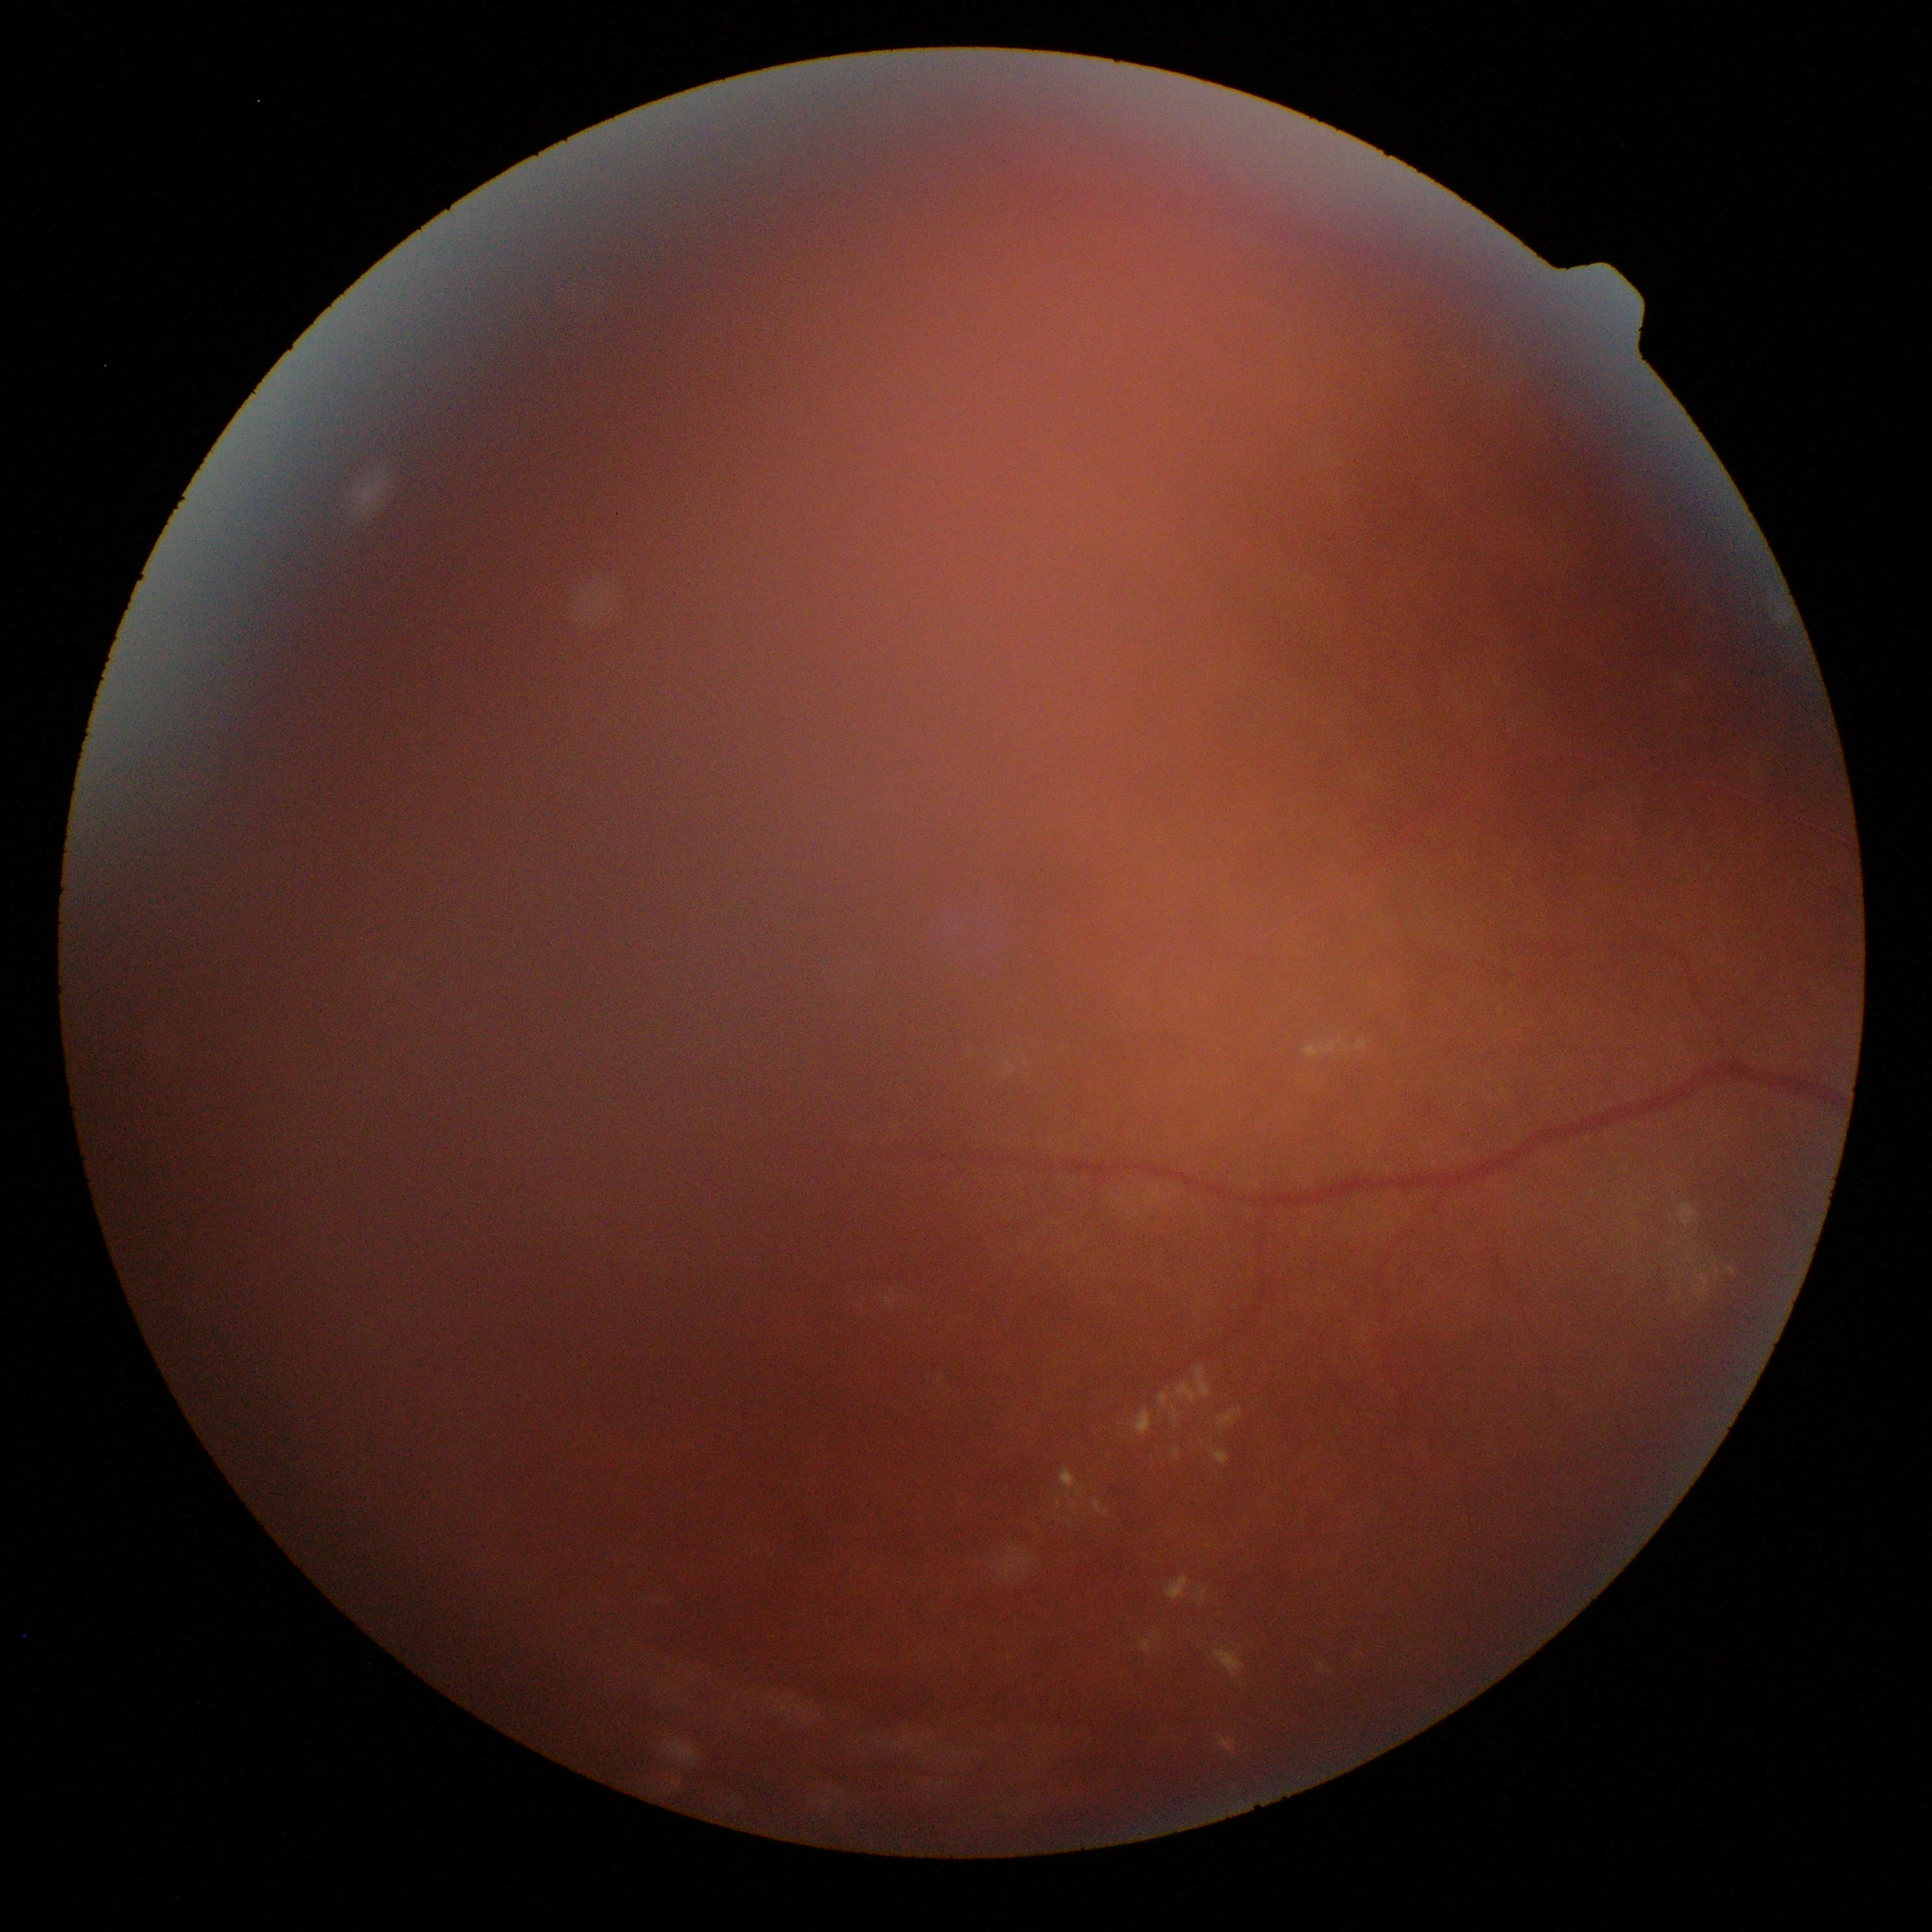

retinopathy grade = 2/4